No pharmacologic dilation · color fundus photograph · 848x848px.
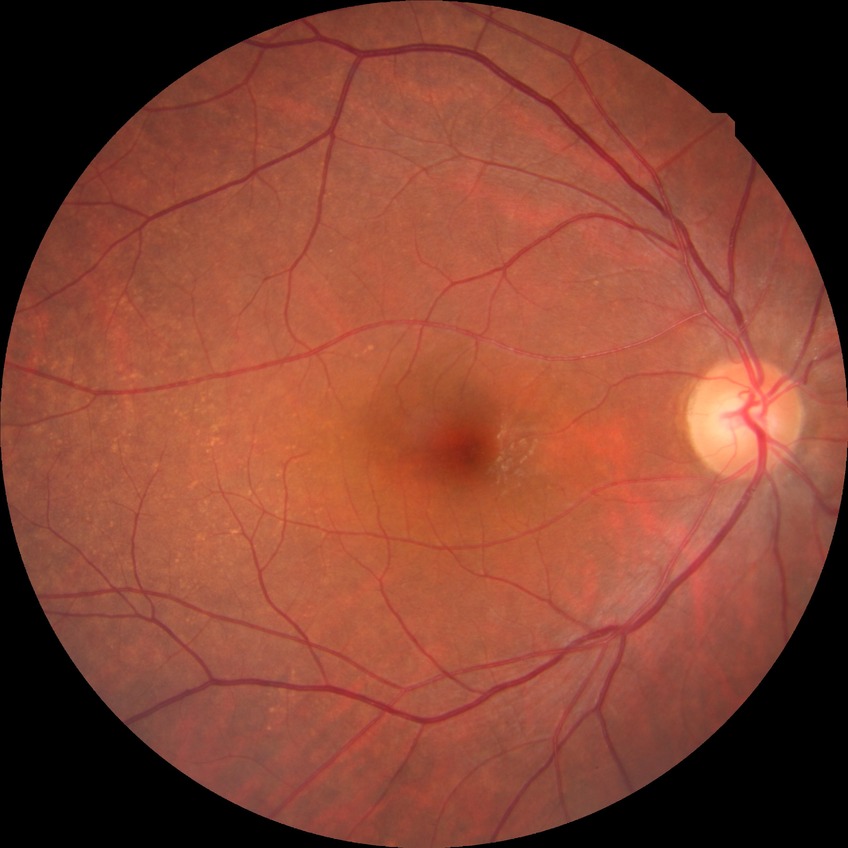

modified Davis classification: no diabetic retinopathy.